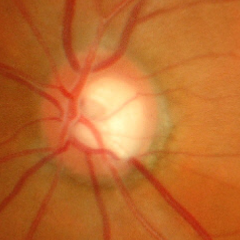

Glaucomatous changes are present. Glaucoma status = advanced glaucoma.